Retinal fundus photograph; 2048x1536px:
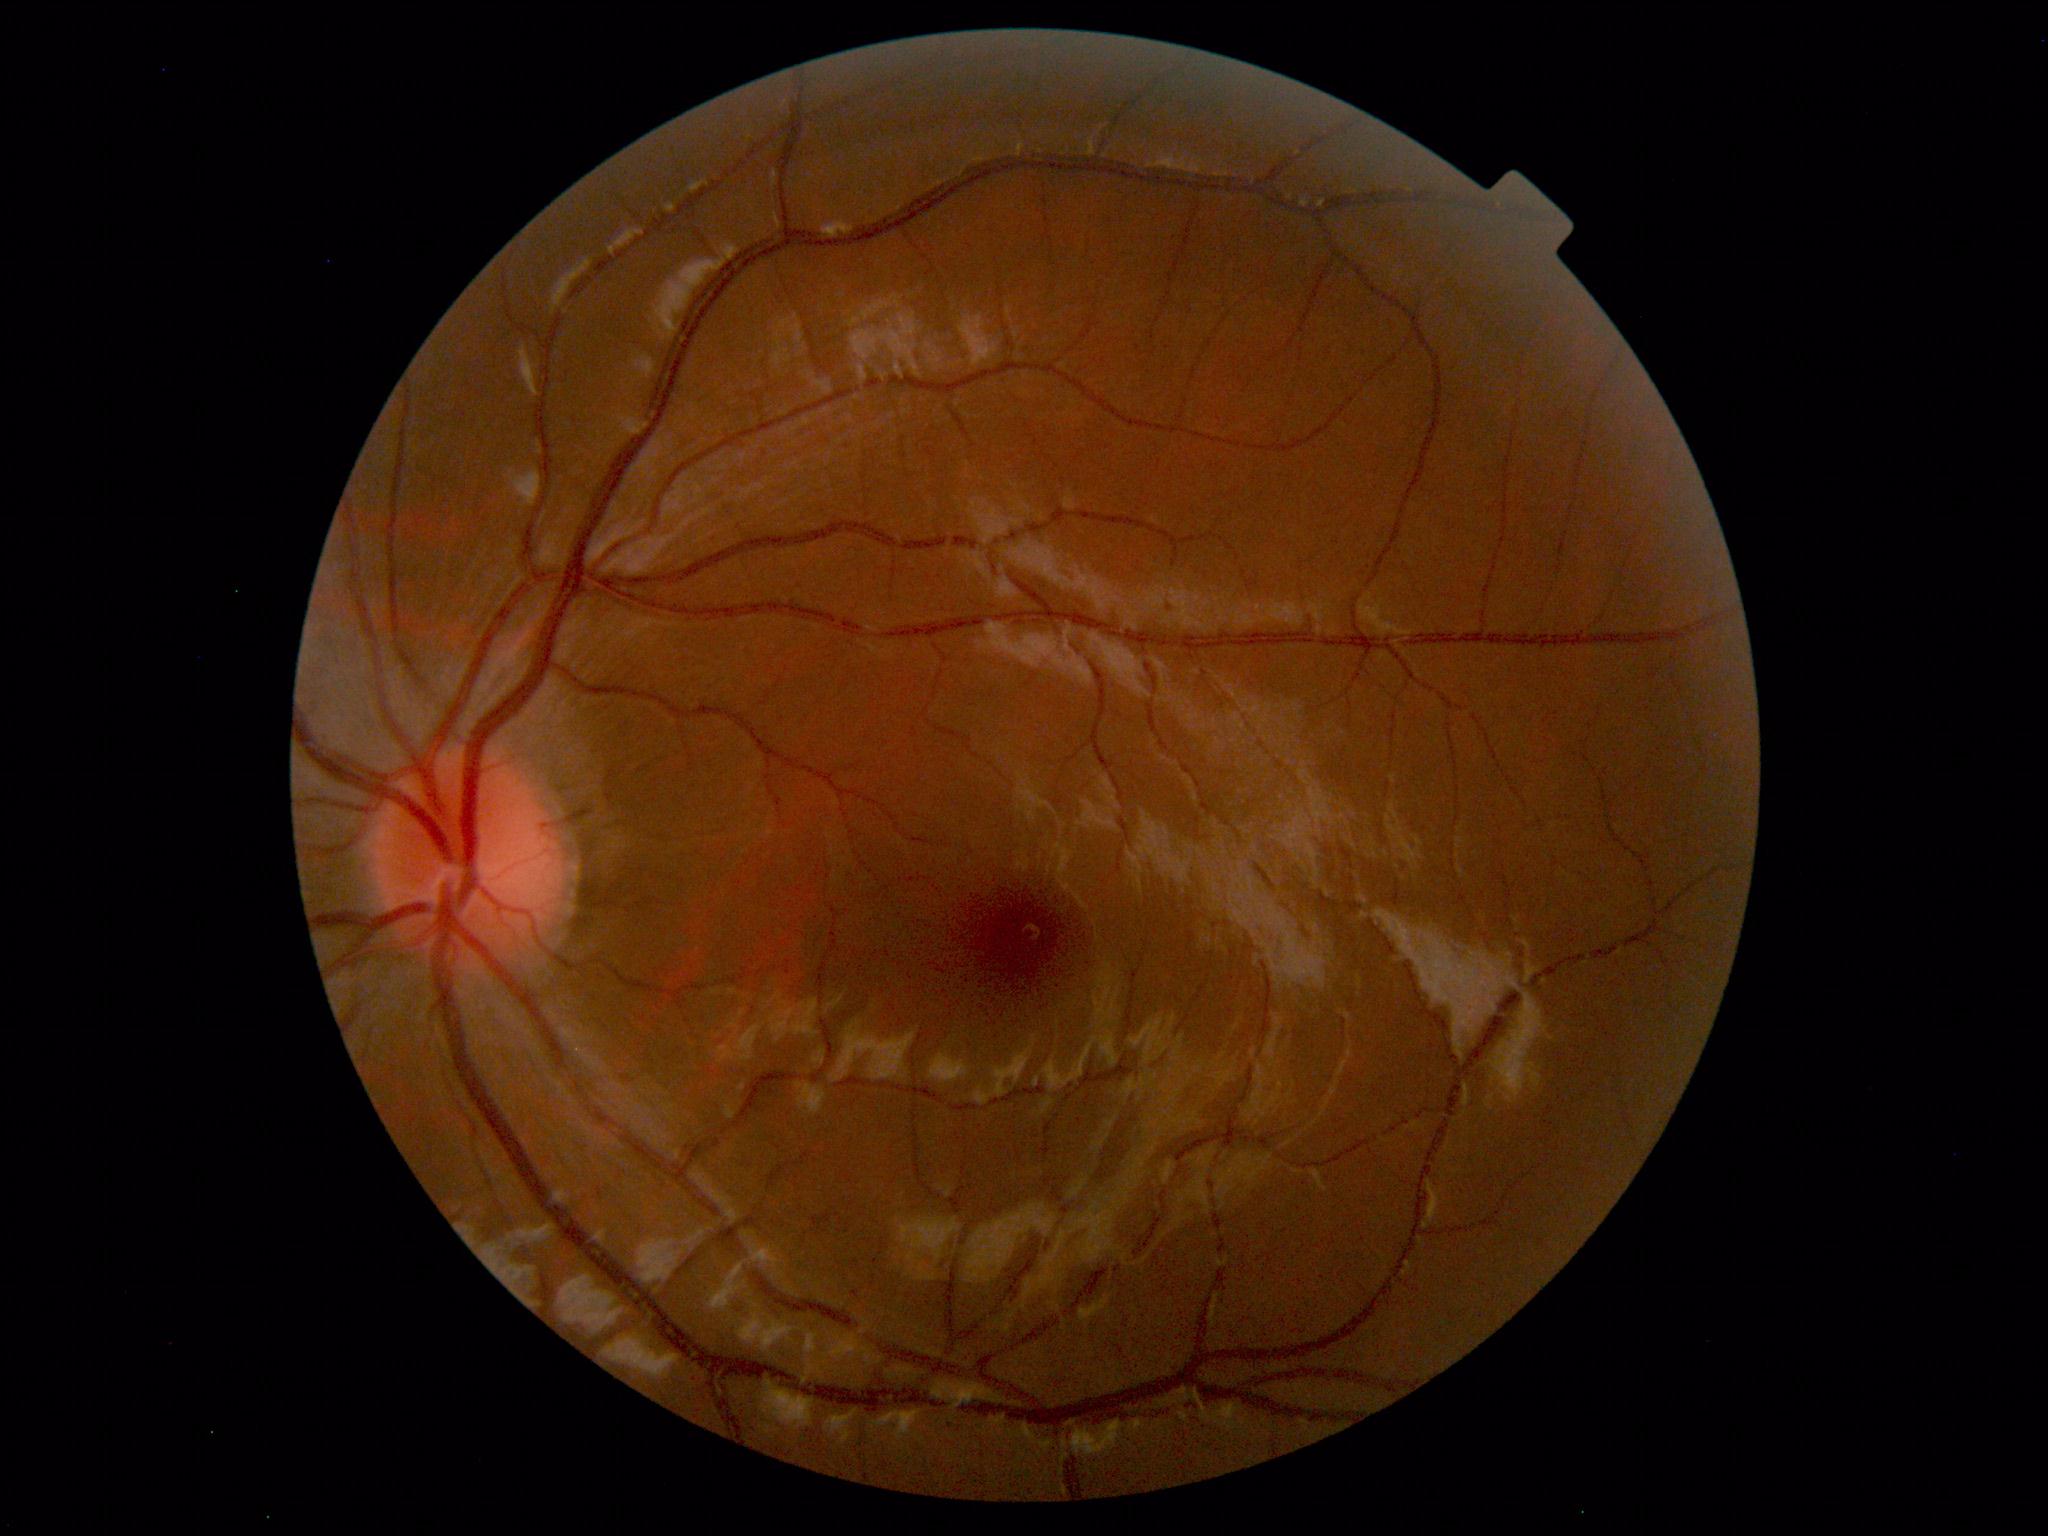 Within normal limits. No abnormalities identified.